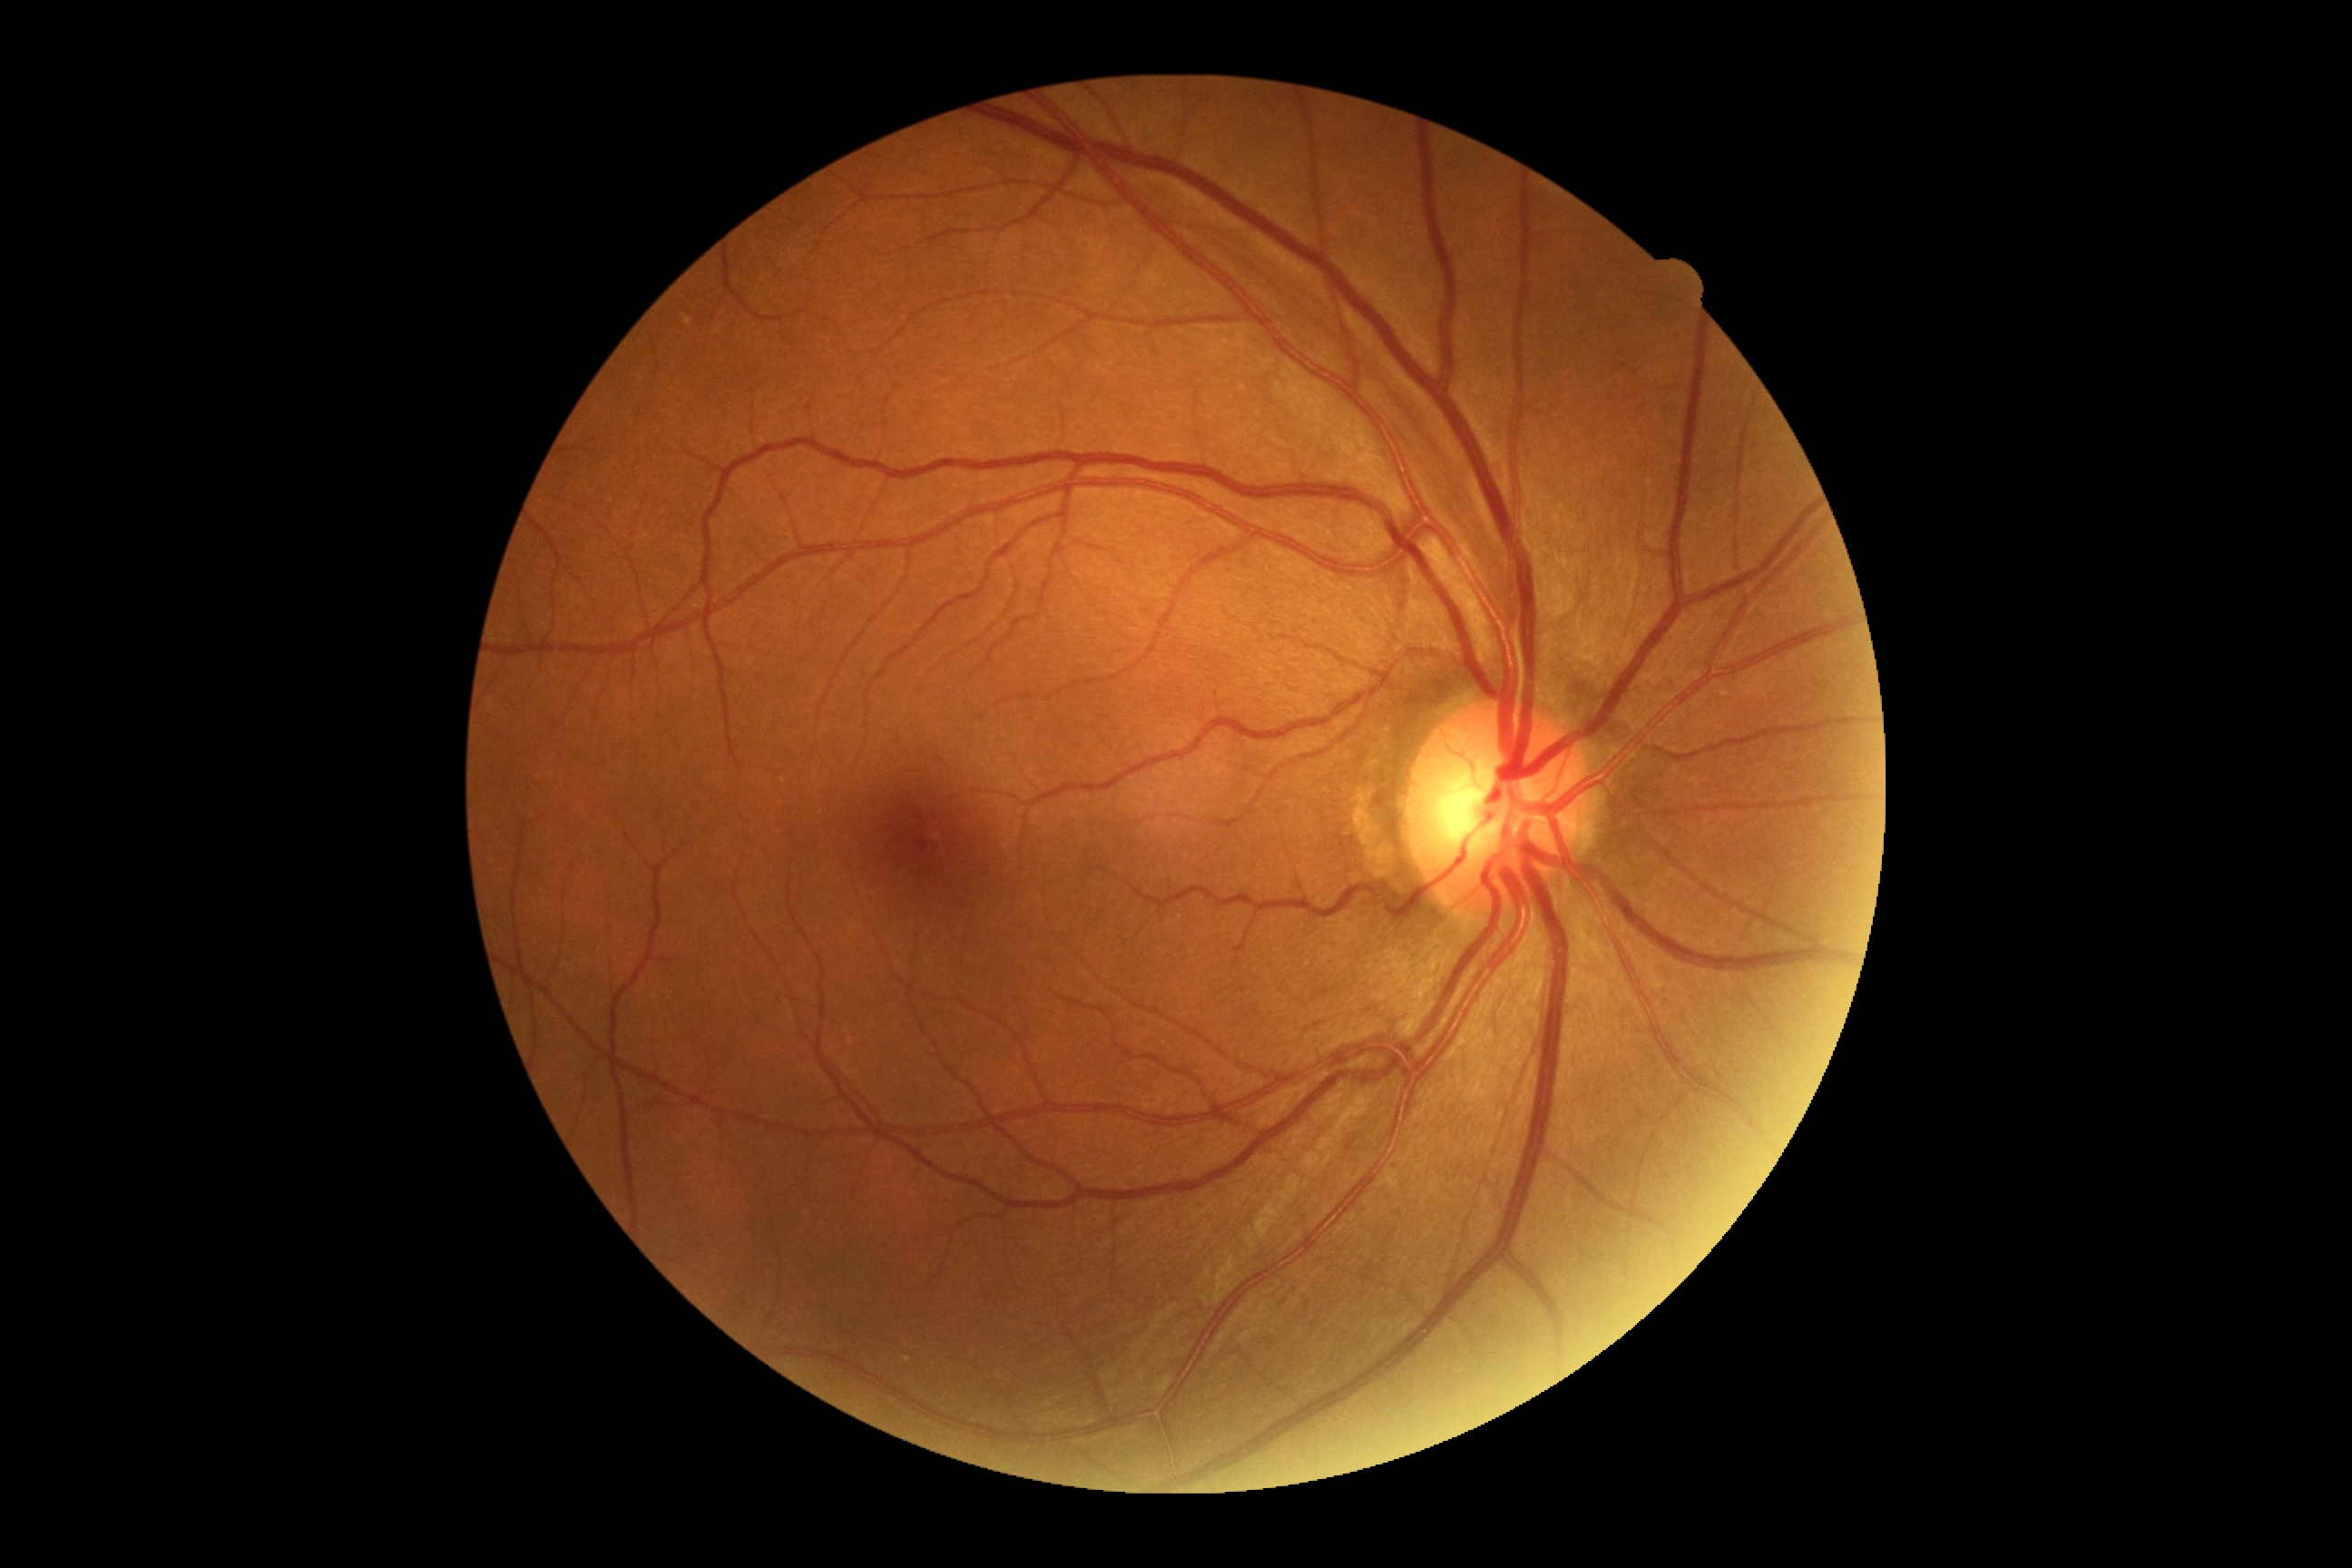
Diabetic retinopathy (DR): grade 0 — no visible signs of diabetic retinopathy.